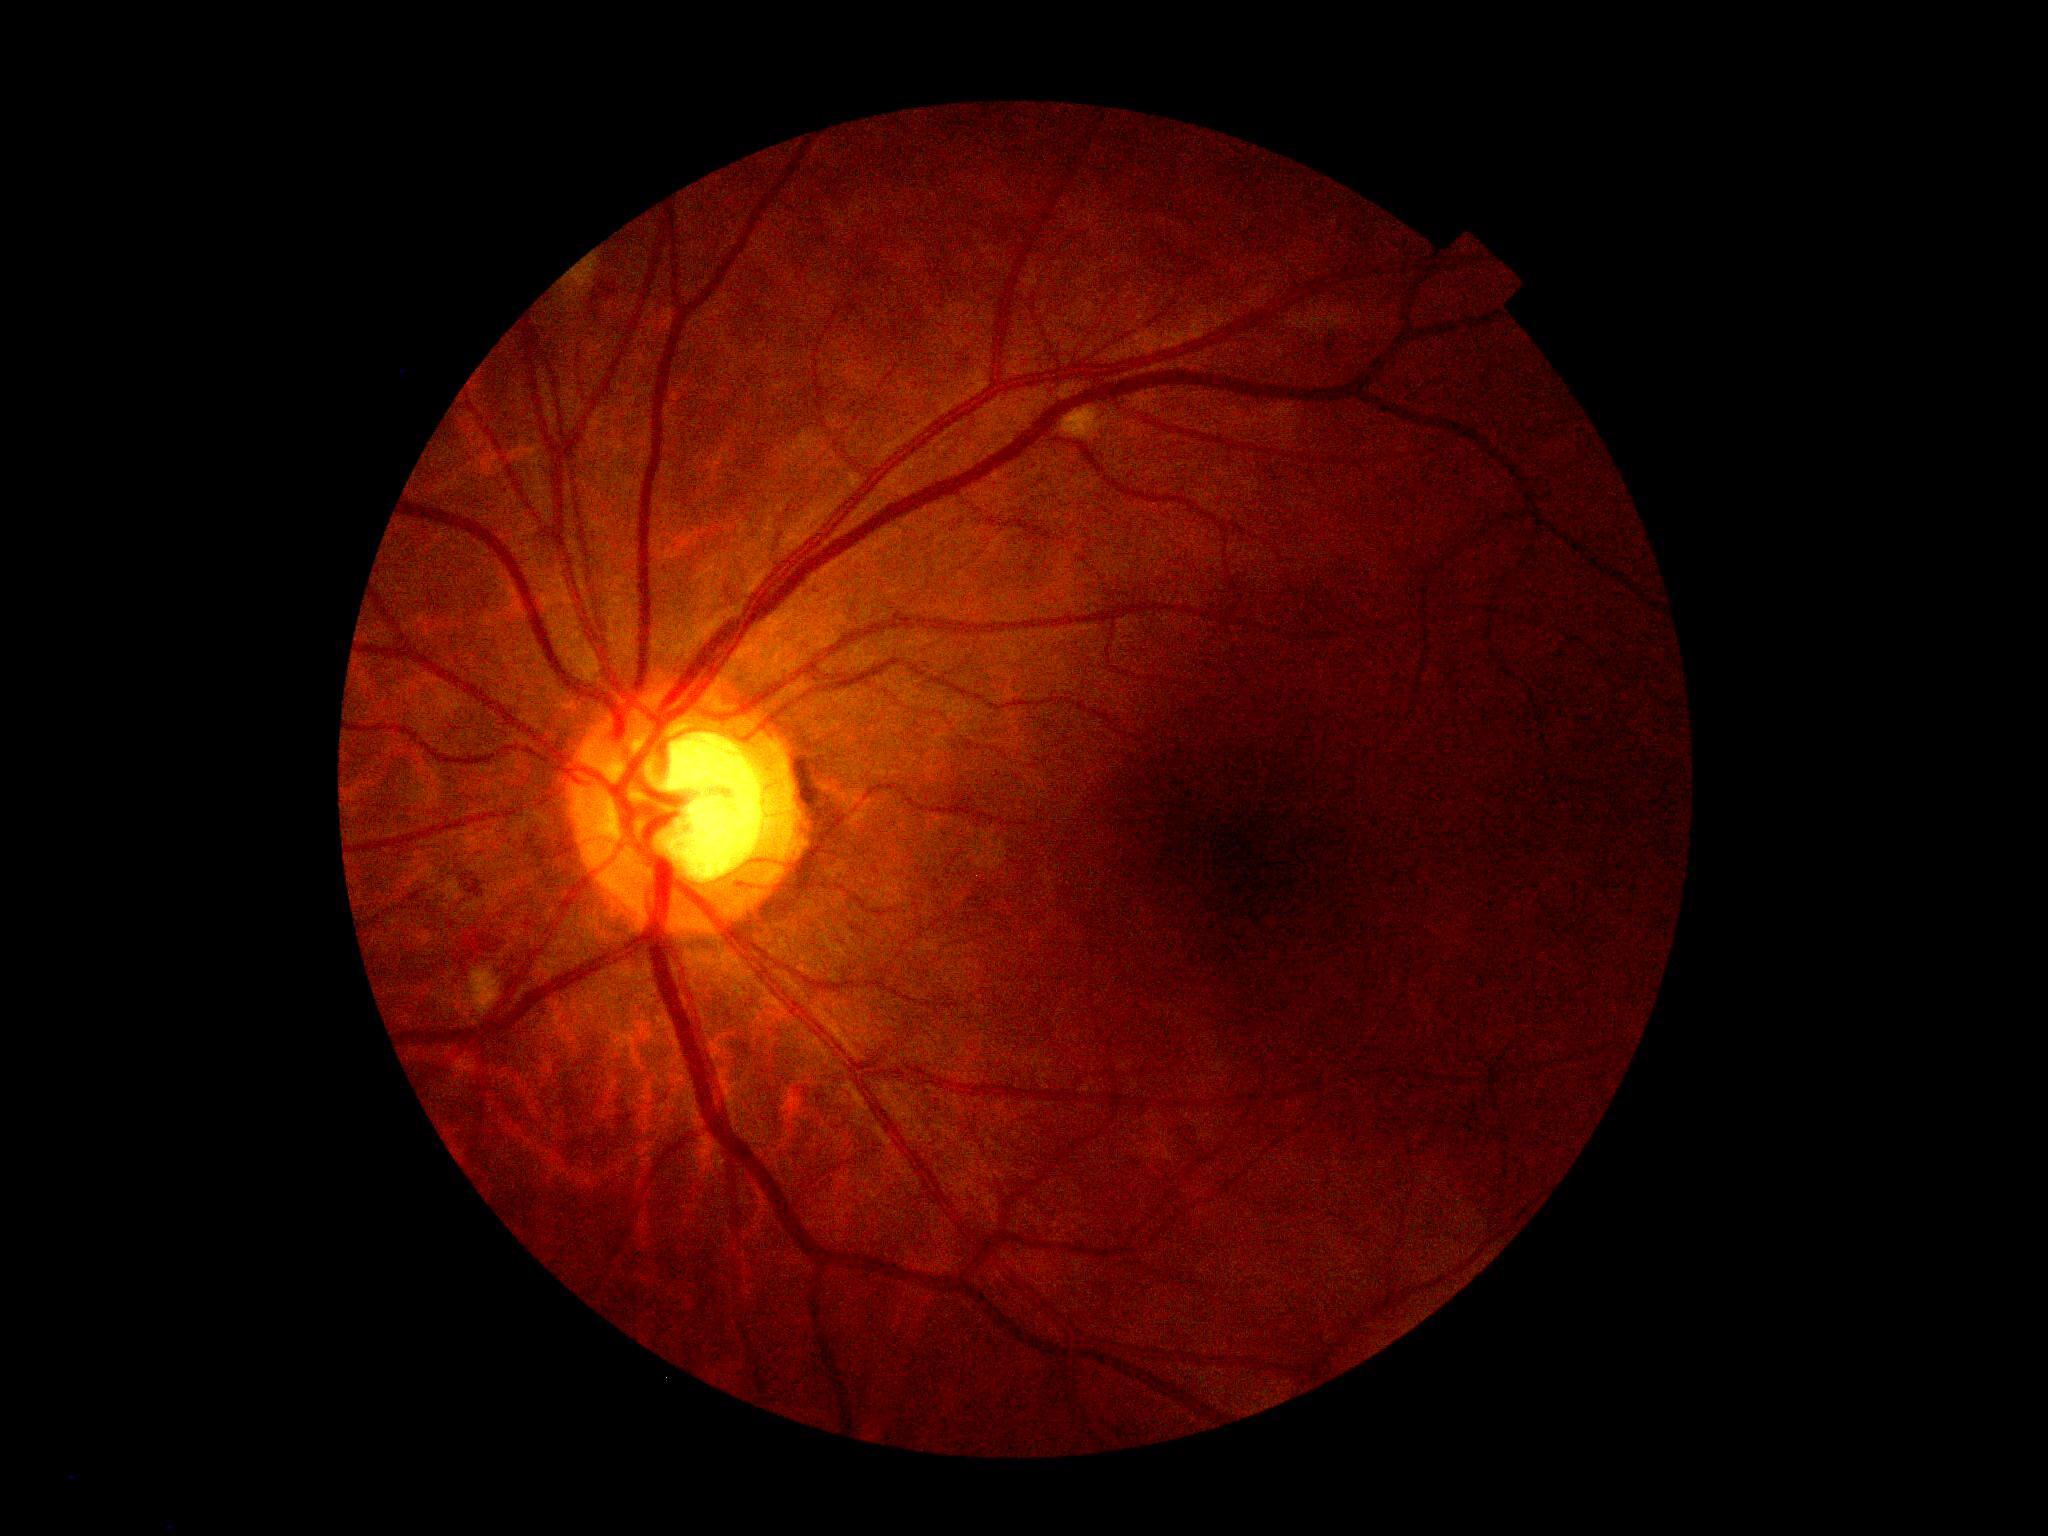 Diabetic retinopathy is grade 2.